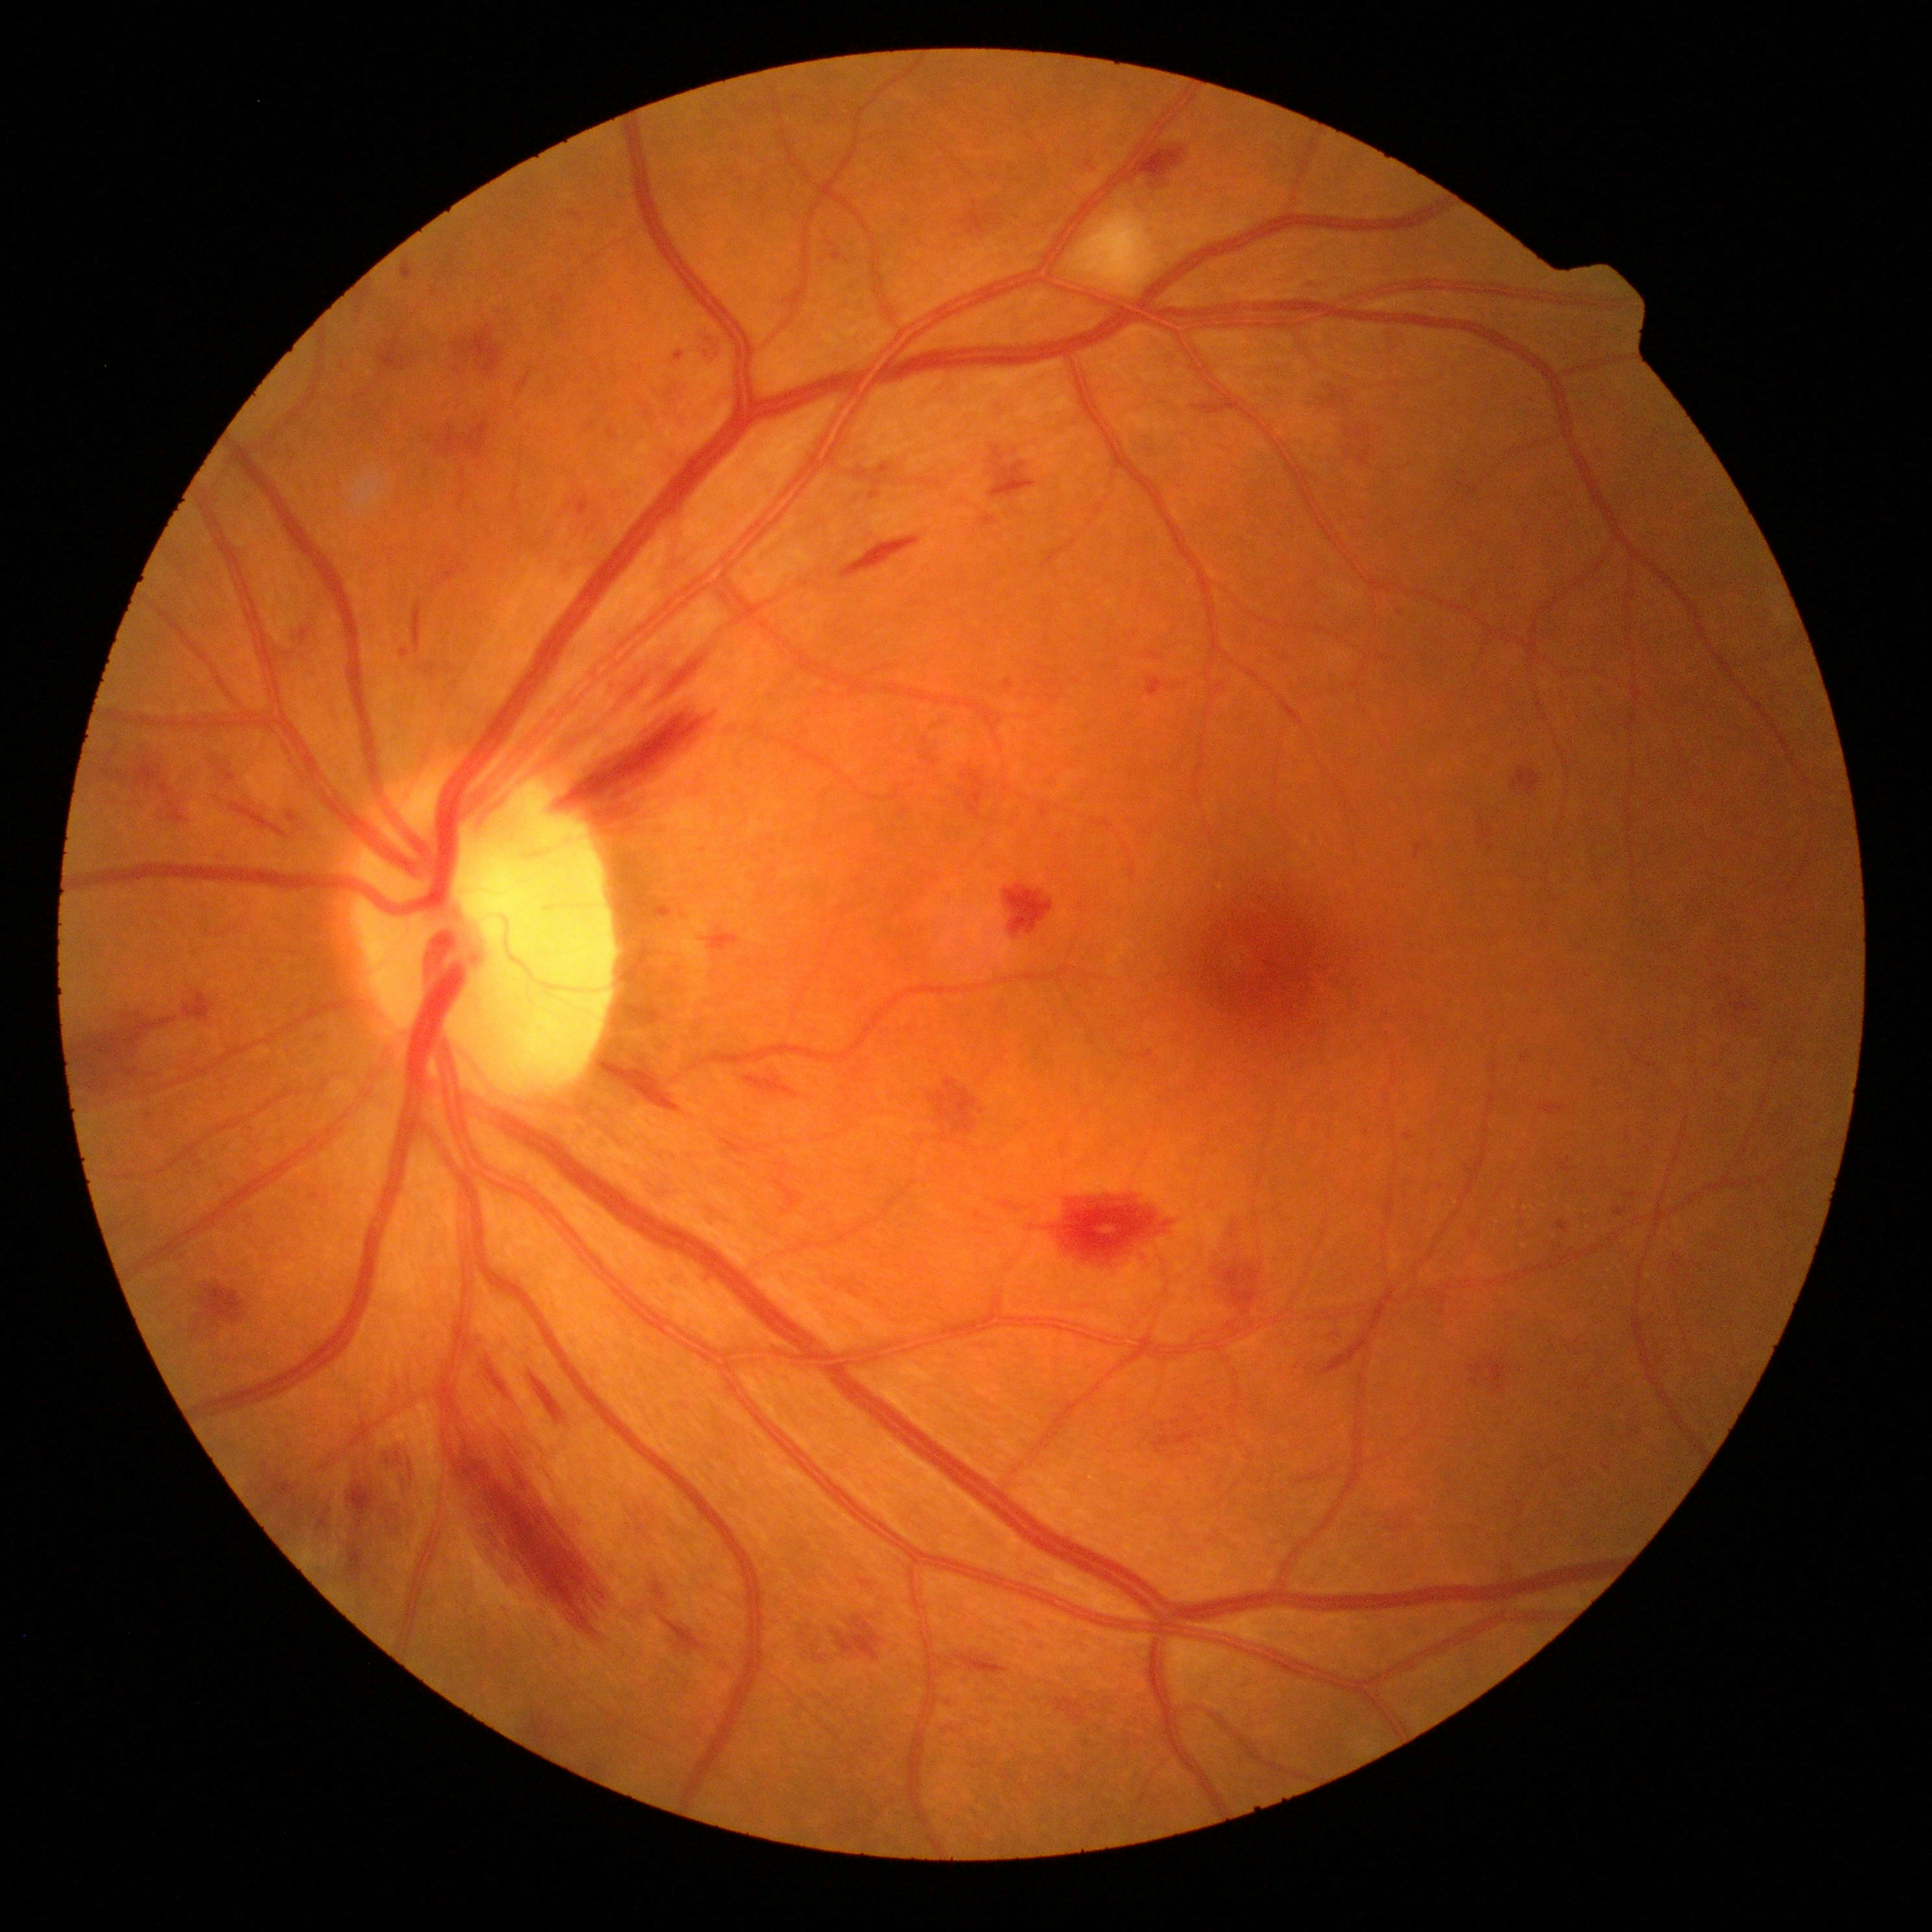
Diabetic retinopathy (DR): grade 2 (moderate NPDR).